CFP. Nonmydriatic. Image size 848x848.
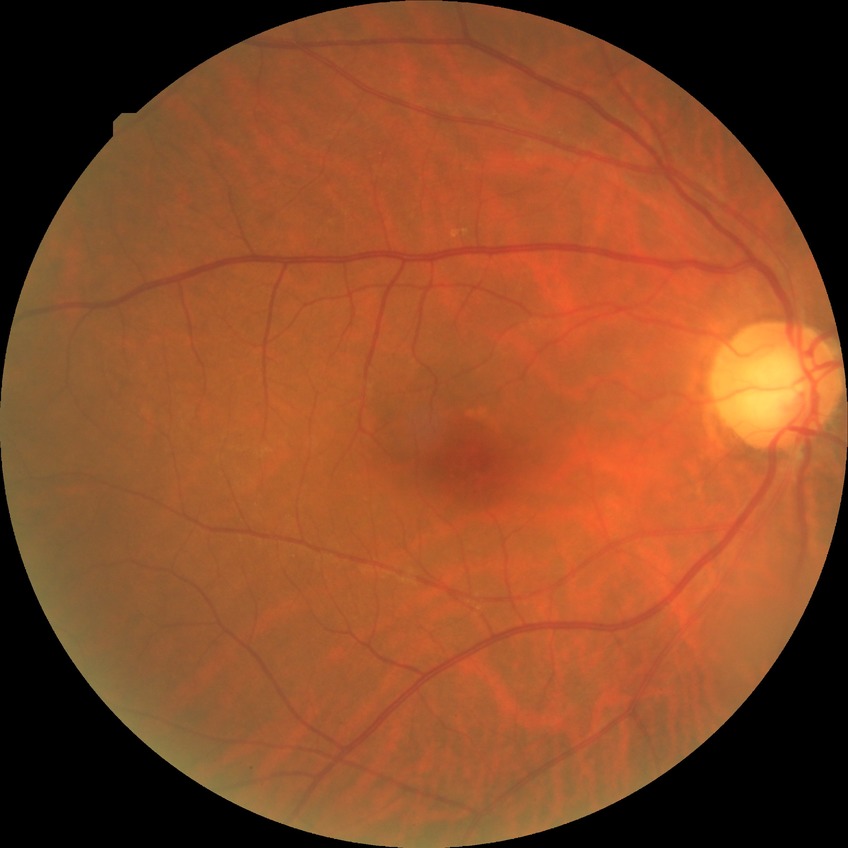

Modified Davis grading: no diabetic retinopathy.